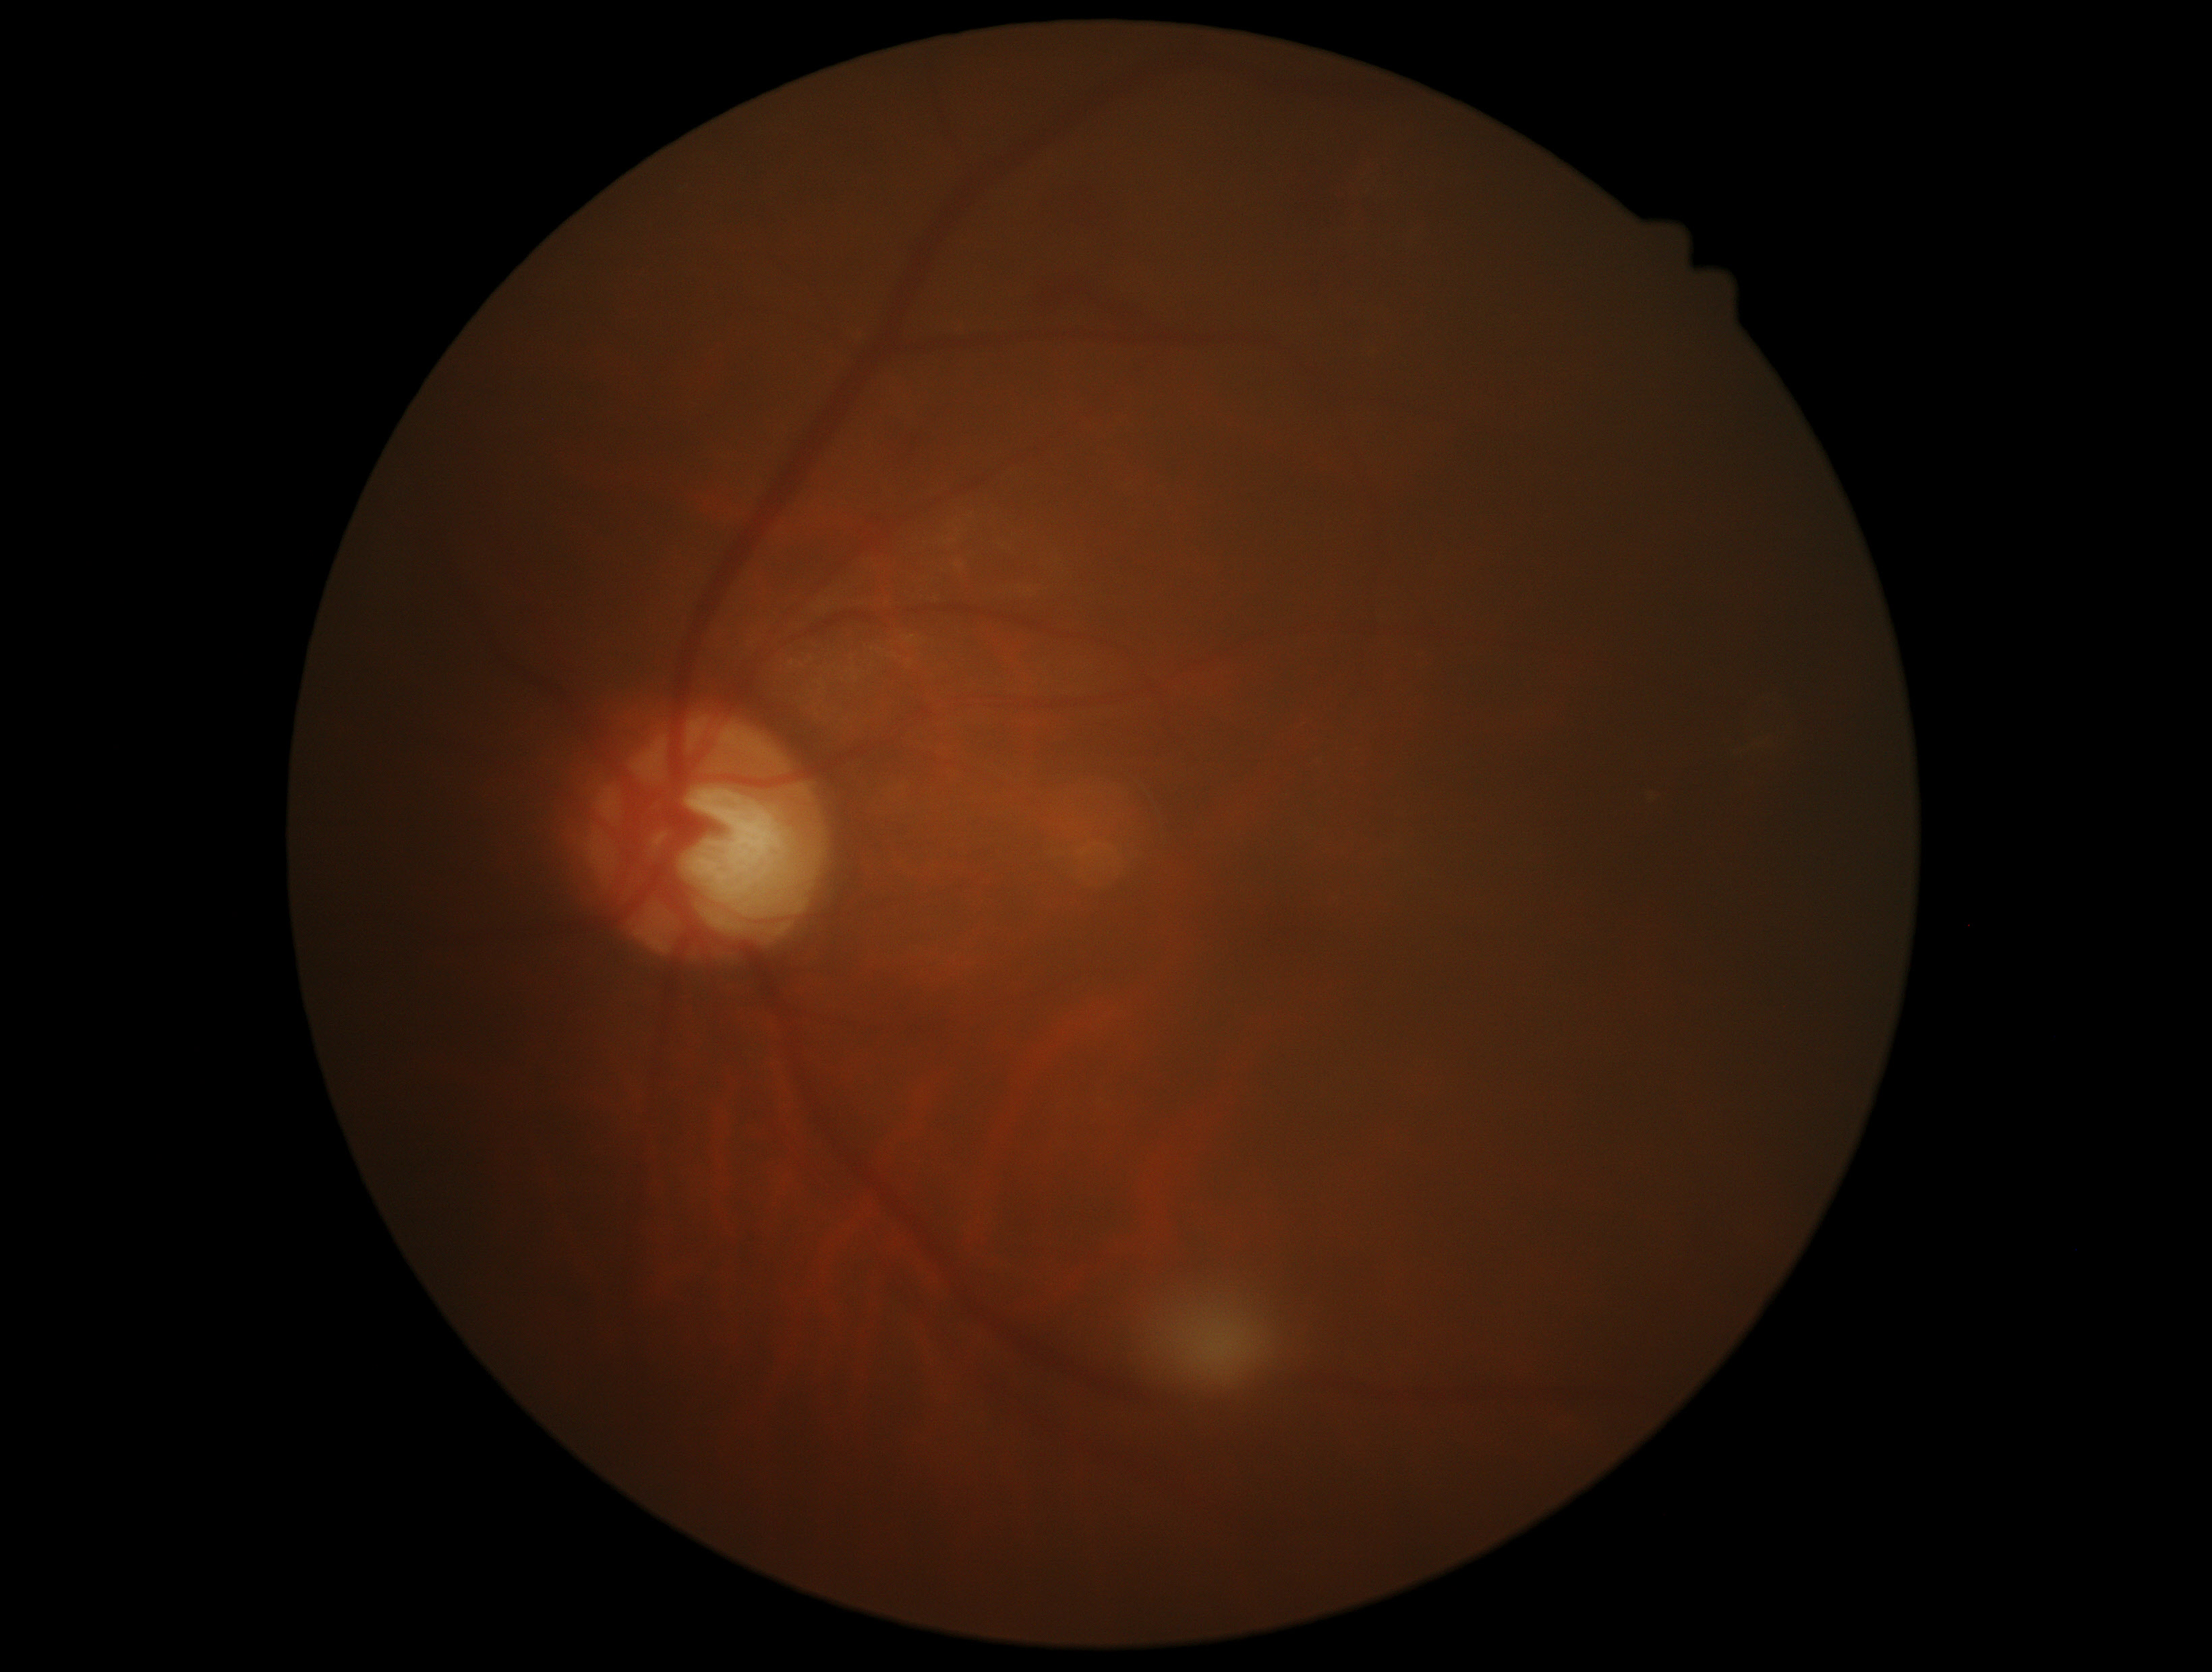
Diabetic retinopathy grade is moderate NPDR (2).